Nonmydriatic fundus photograph · camera: NIDEK AFC-230 — 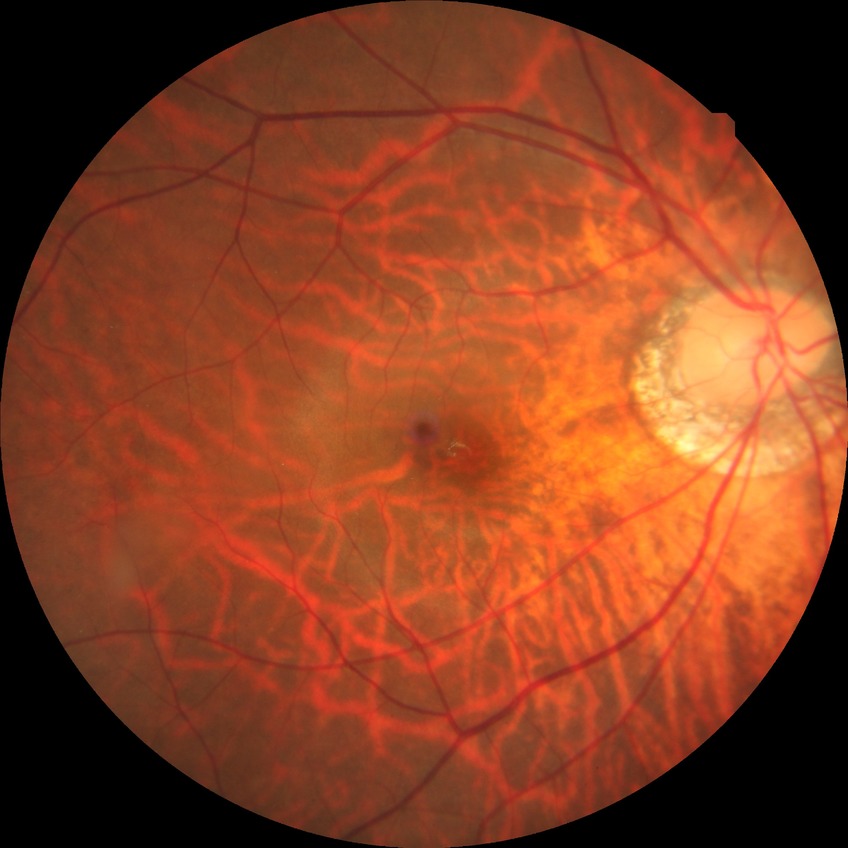 Davis DR grade: NDR.
No signs of diabetic retinopathy.